Patient age: 64 years. Pachymetry: 531 µm. Optic disc at the center of the field: 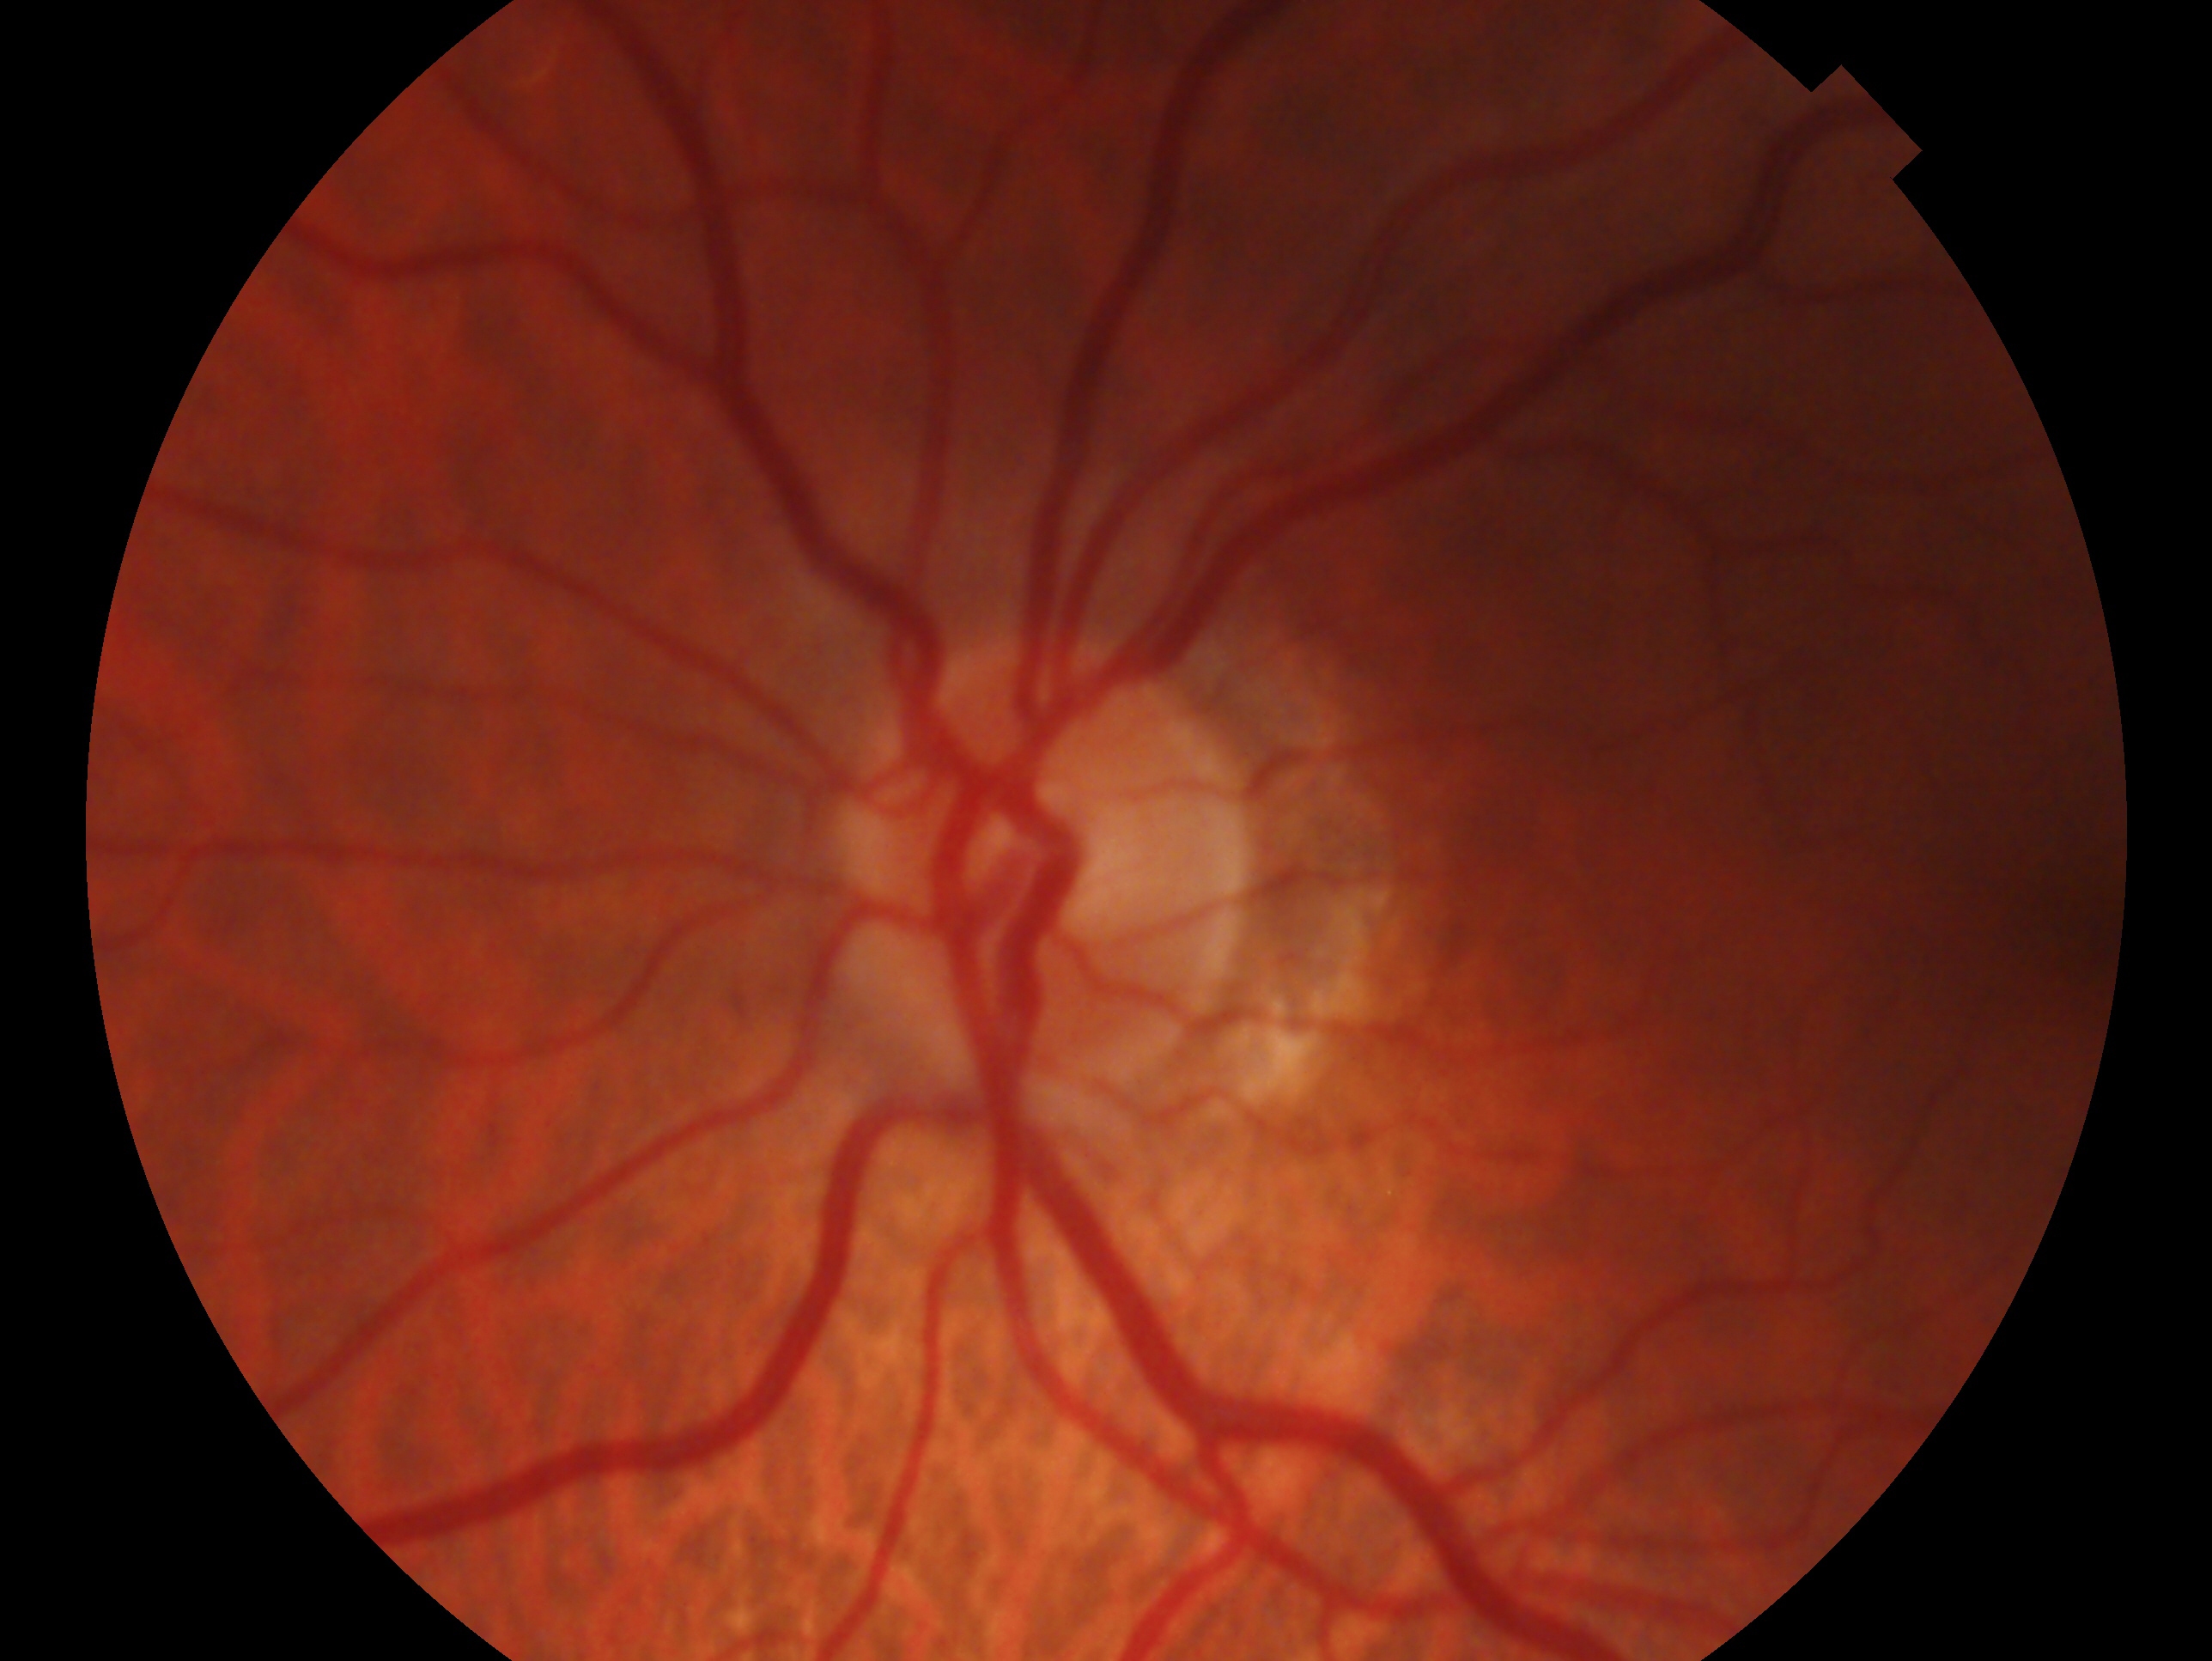 laterality: left eye
glaucoma status: no glaucoma